45° field of view; NIDEK AFC-230 — 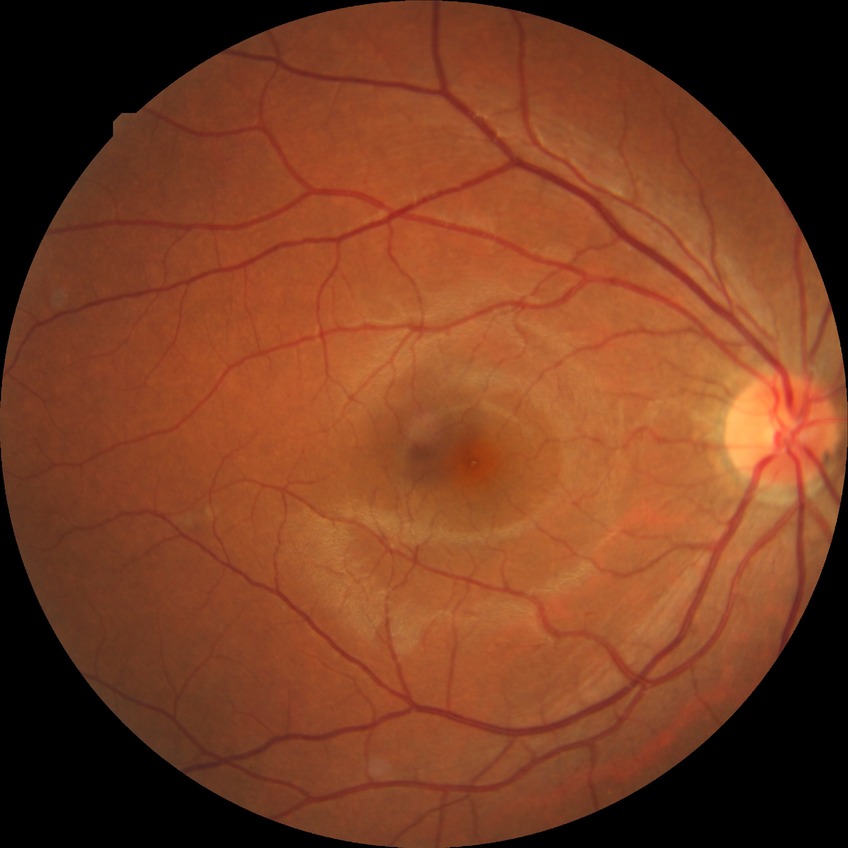
Annotations:
• diabetic retinopathy (DR): simple diabetic retinopathy (SDR)